Captured on a Remidio FOP fundus camera
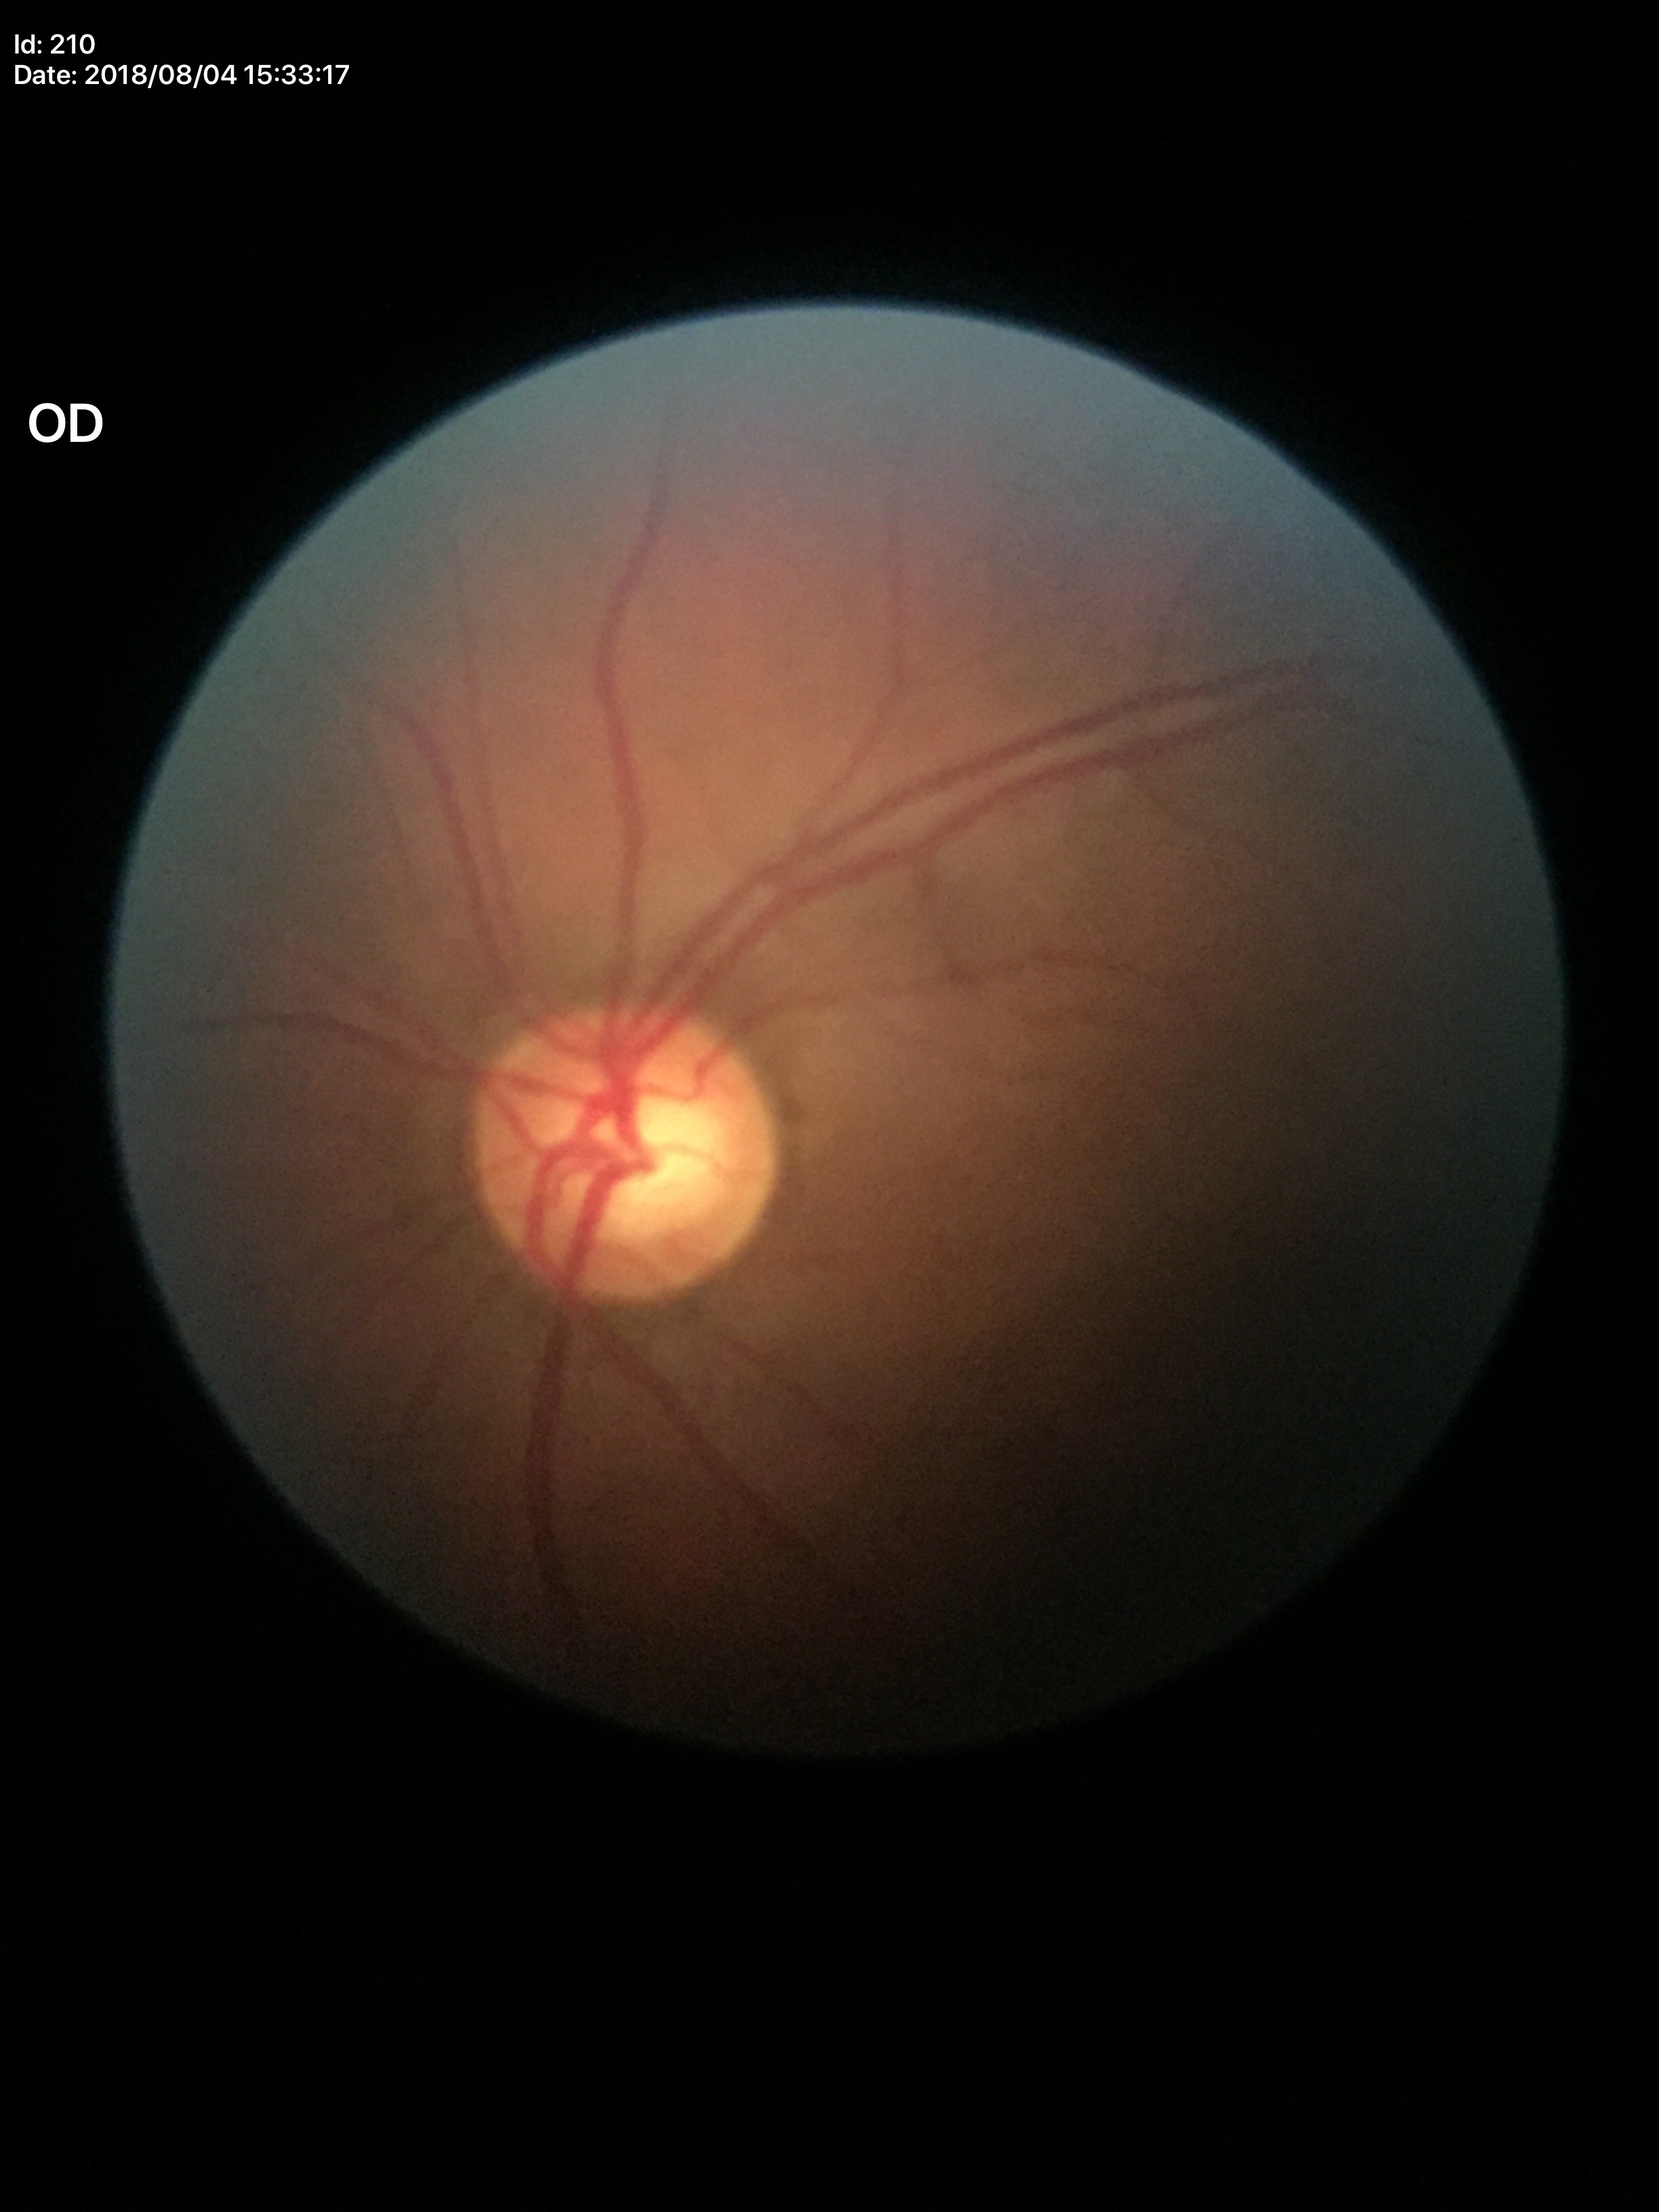

Glaucoma-suspect optic disc appearance.
Vertical C/D ratio is 0.61.
Horizontal CDR: 0.66.